848x848: 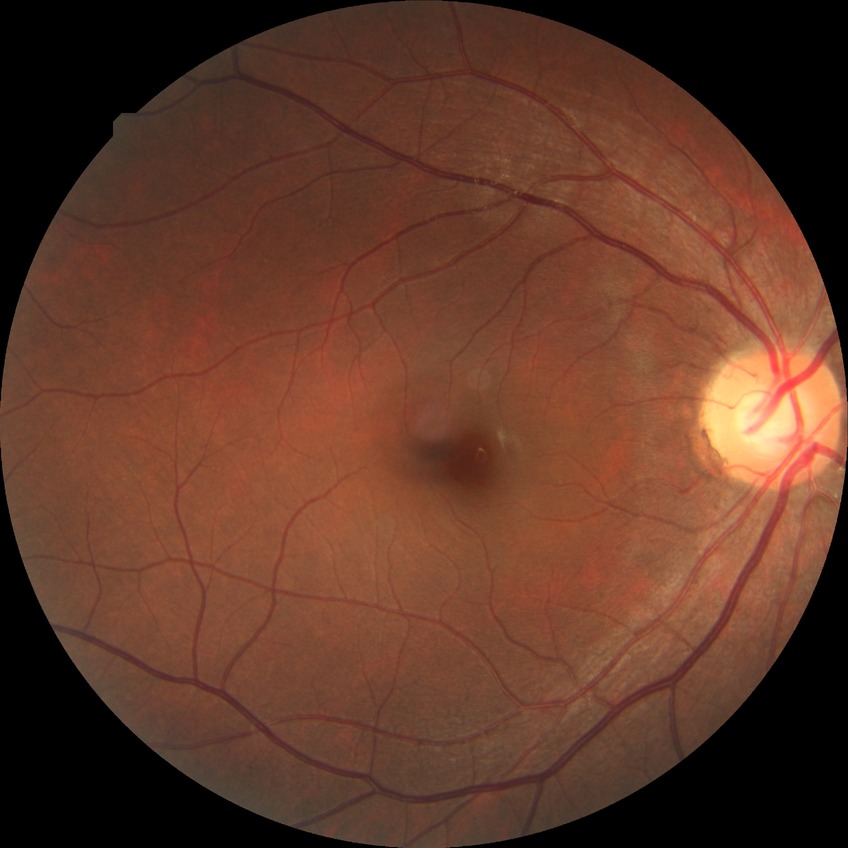

modified Davis grading: no diabetic retinopathy.